Retinal fundus photograph · 50-degree field of view.
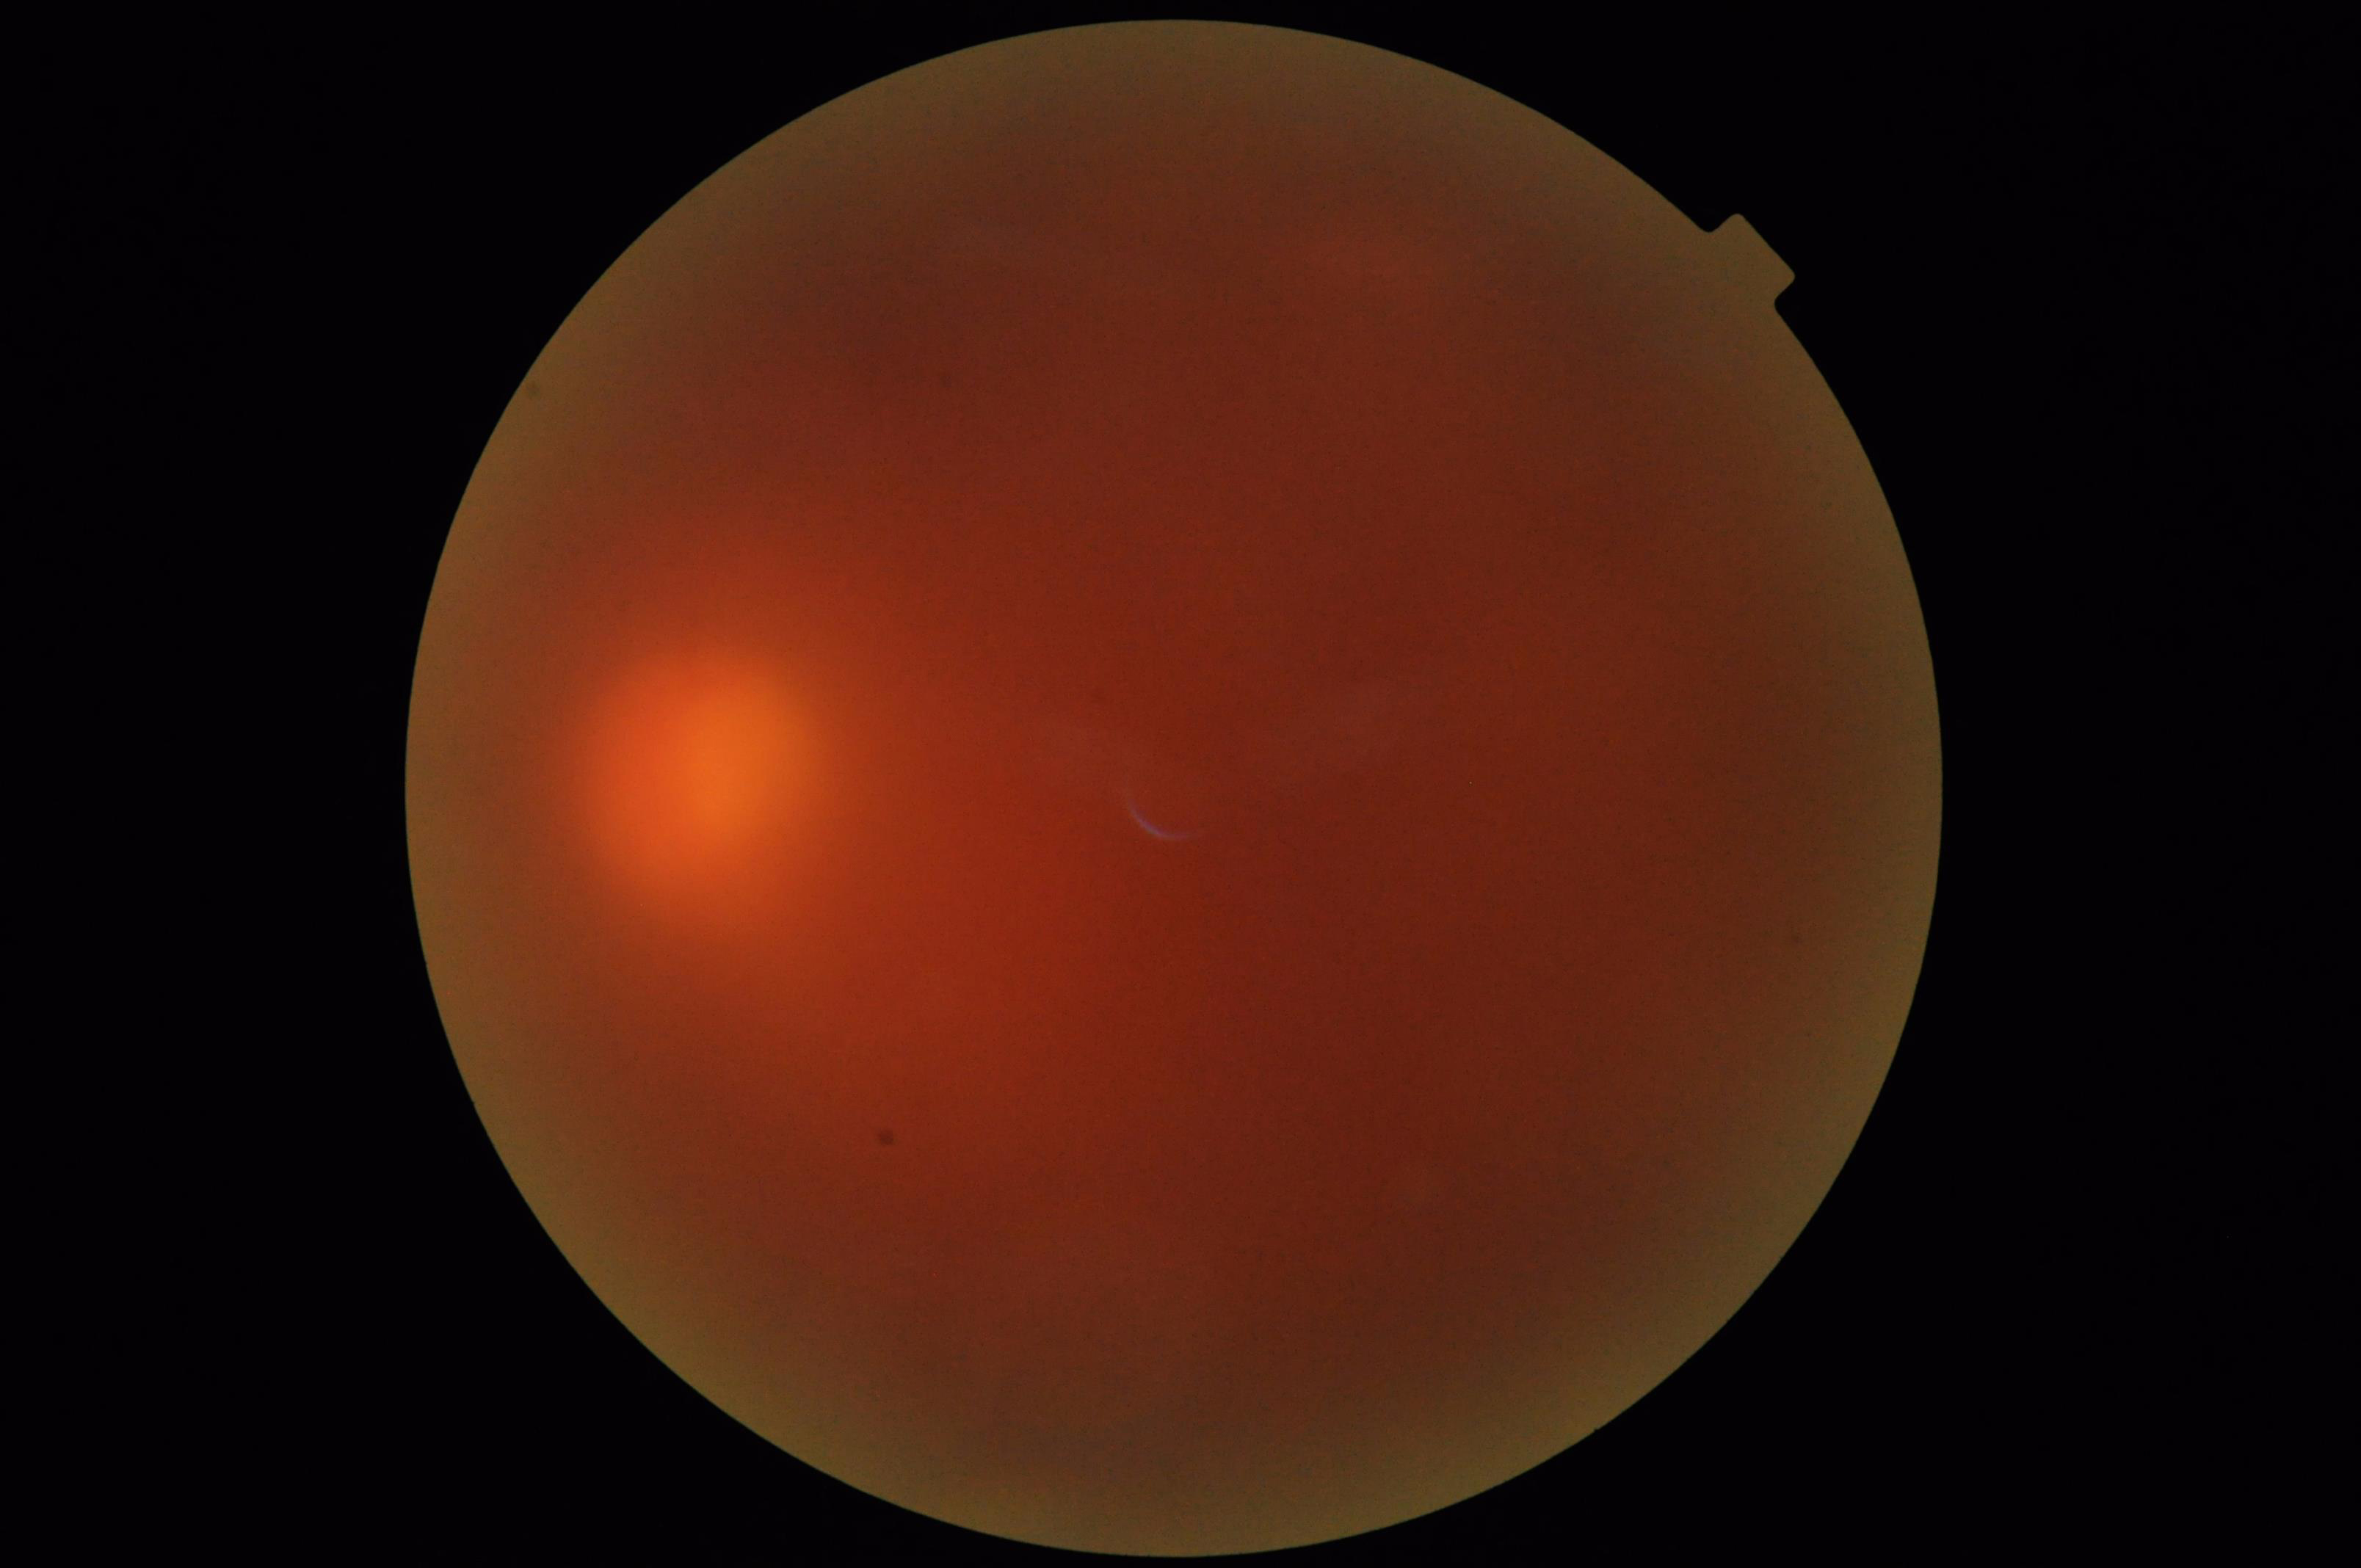
{"illumination": "poor", "overall_quality": "poor", "contrast": "low", "clarity": "blurry"}